Diabetic retinopathy graded by the modified Davis classification, camera: NIDEK AFC-230, FOV: 45 degrees, 848 by 848 pixels, color fundus image.
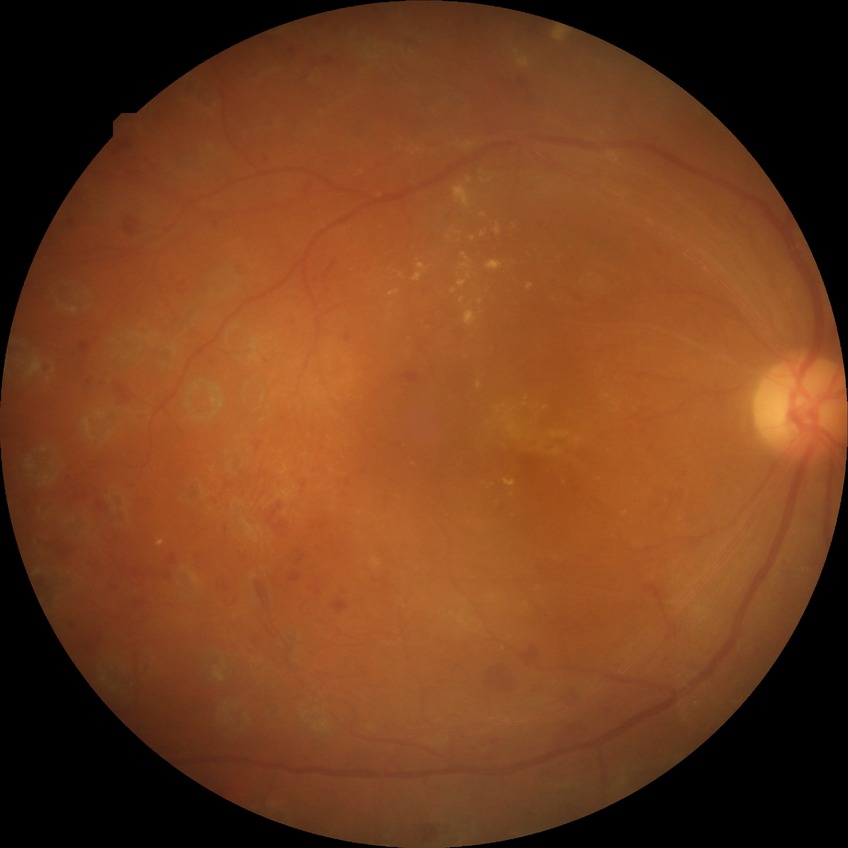
davis_grade: PDR (proliferative diabetic retinopathy)